60° FOV. Color fundus photograph from a handheld portable camera.
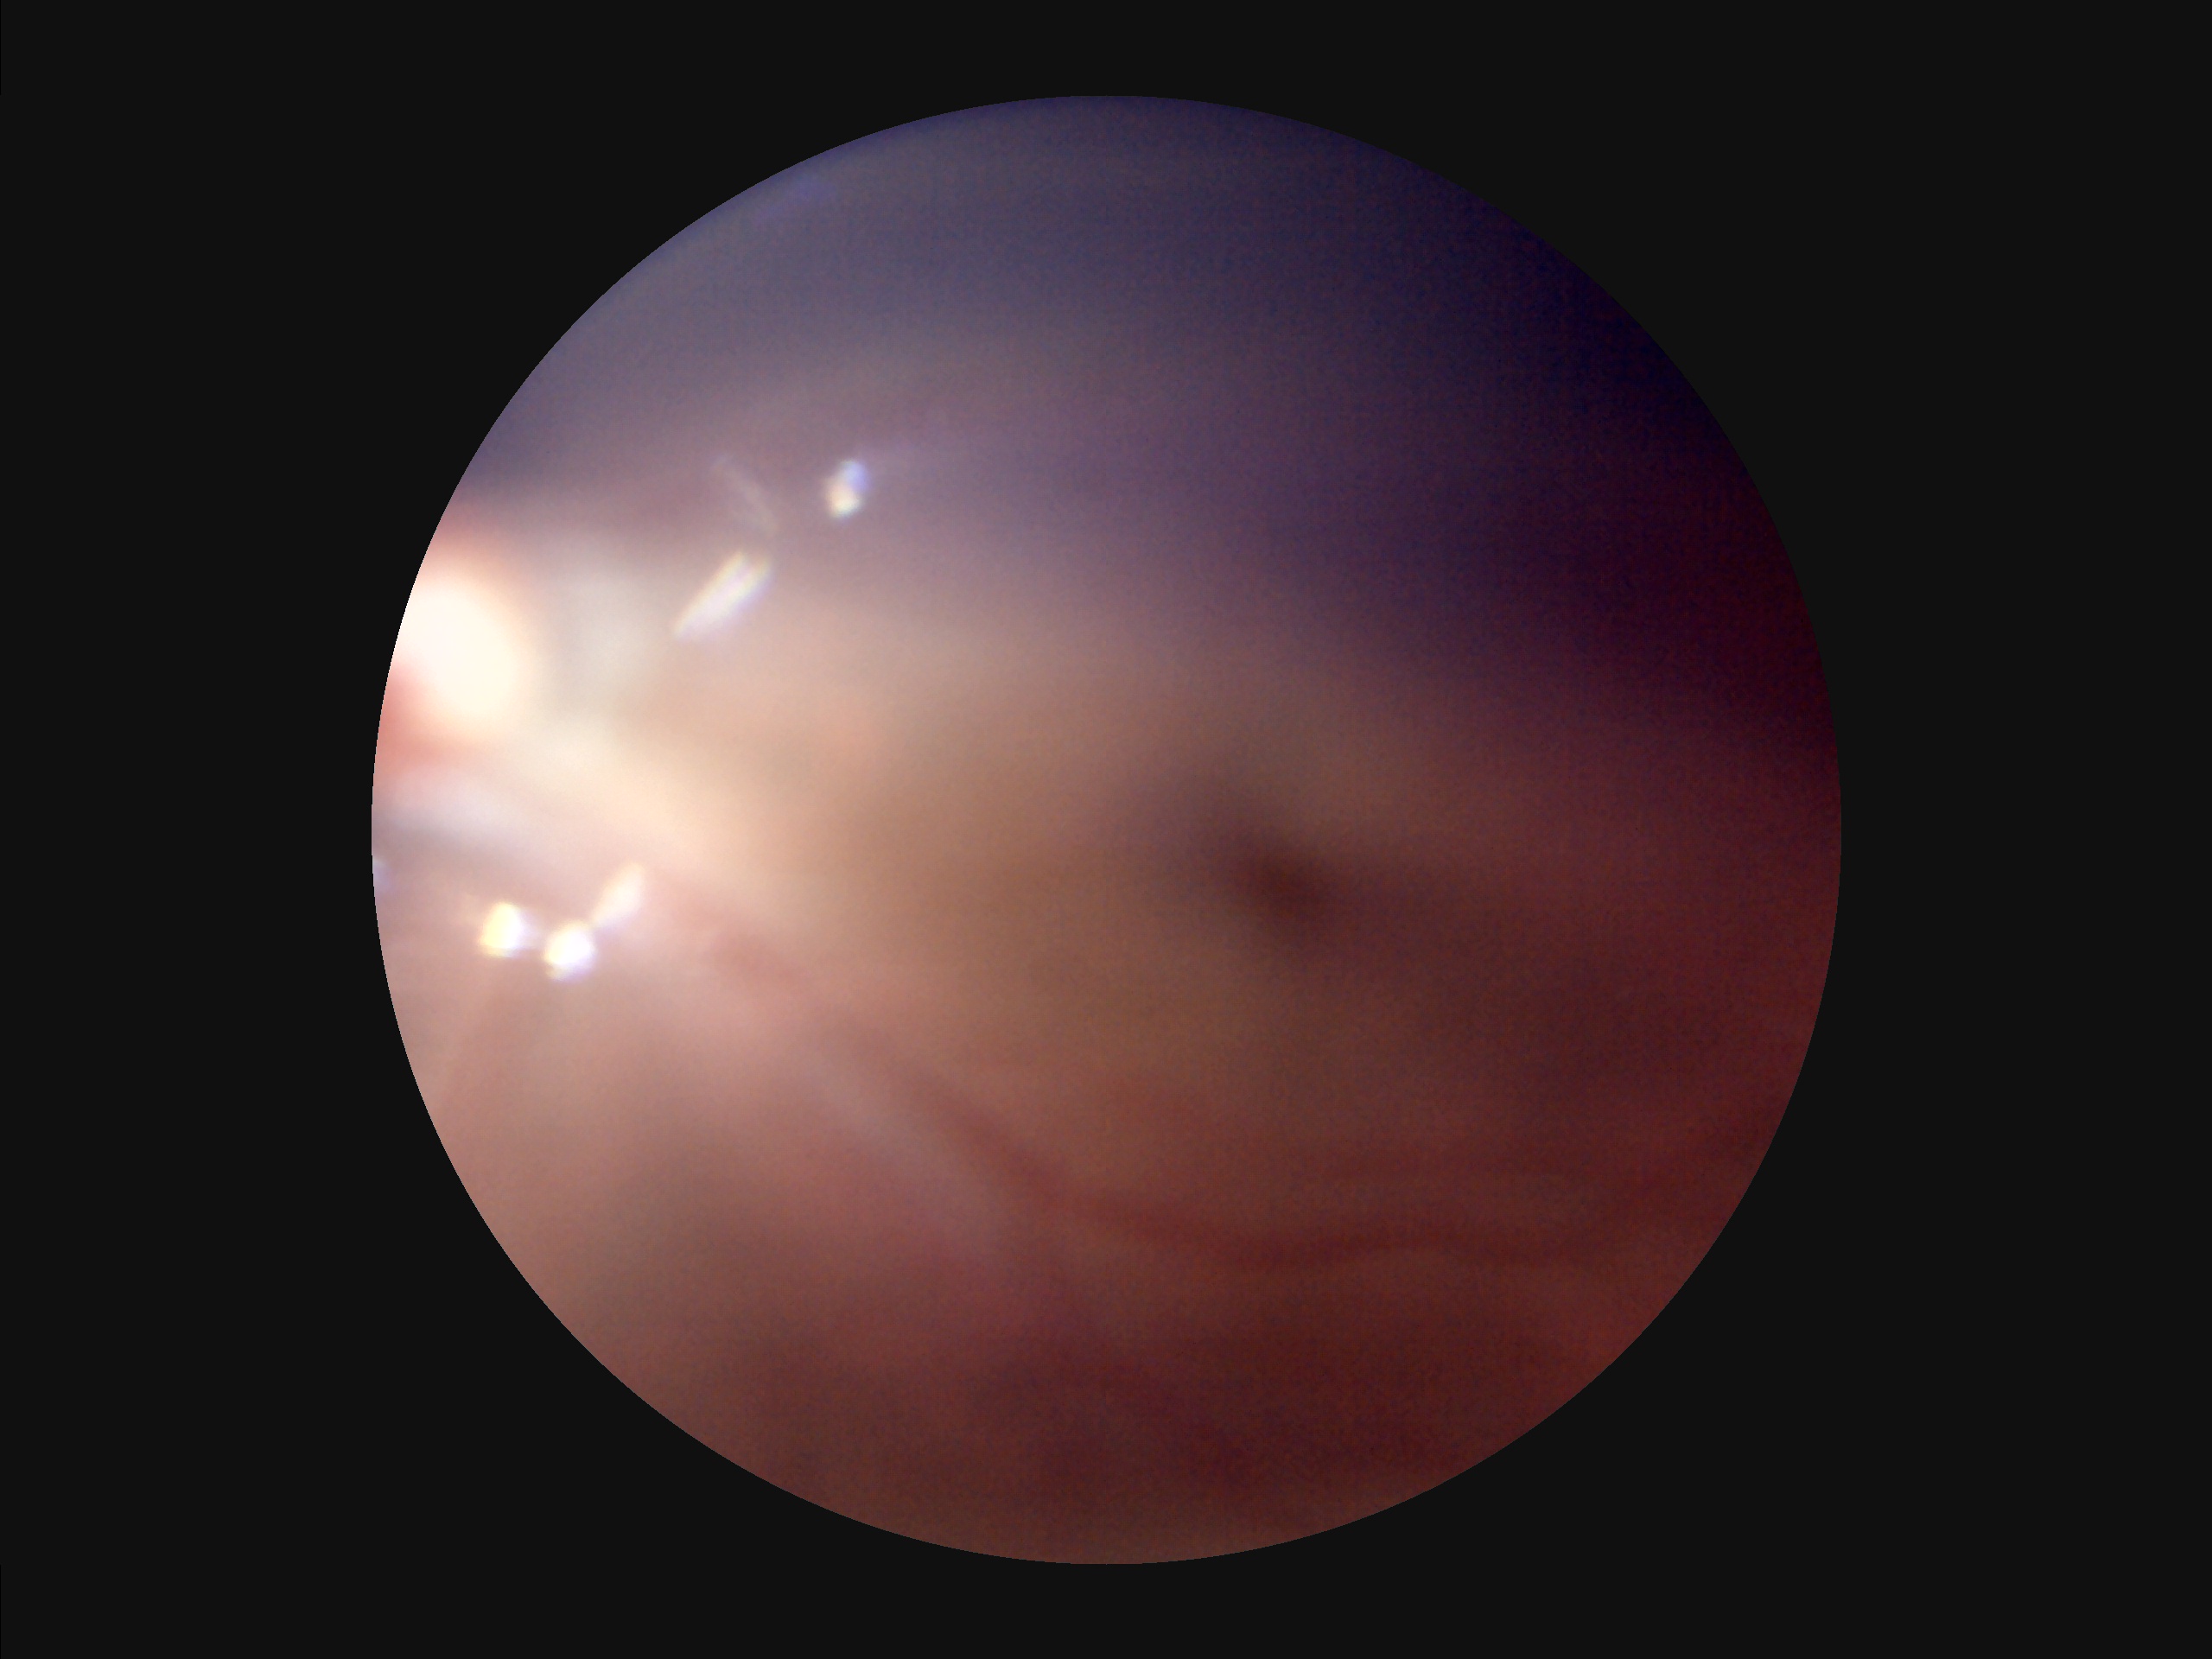 Overall: poor | Sharpness: poor | Contrast: reduced | Illumination: suboptimal.